2352 by 1568 pixels · CFP — 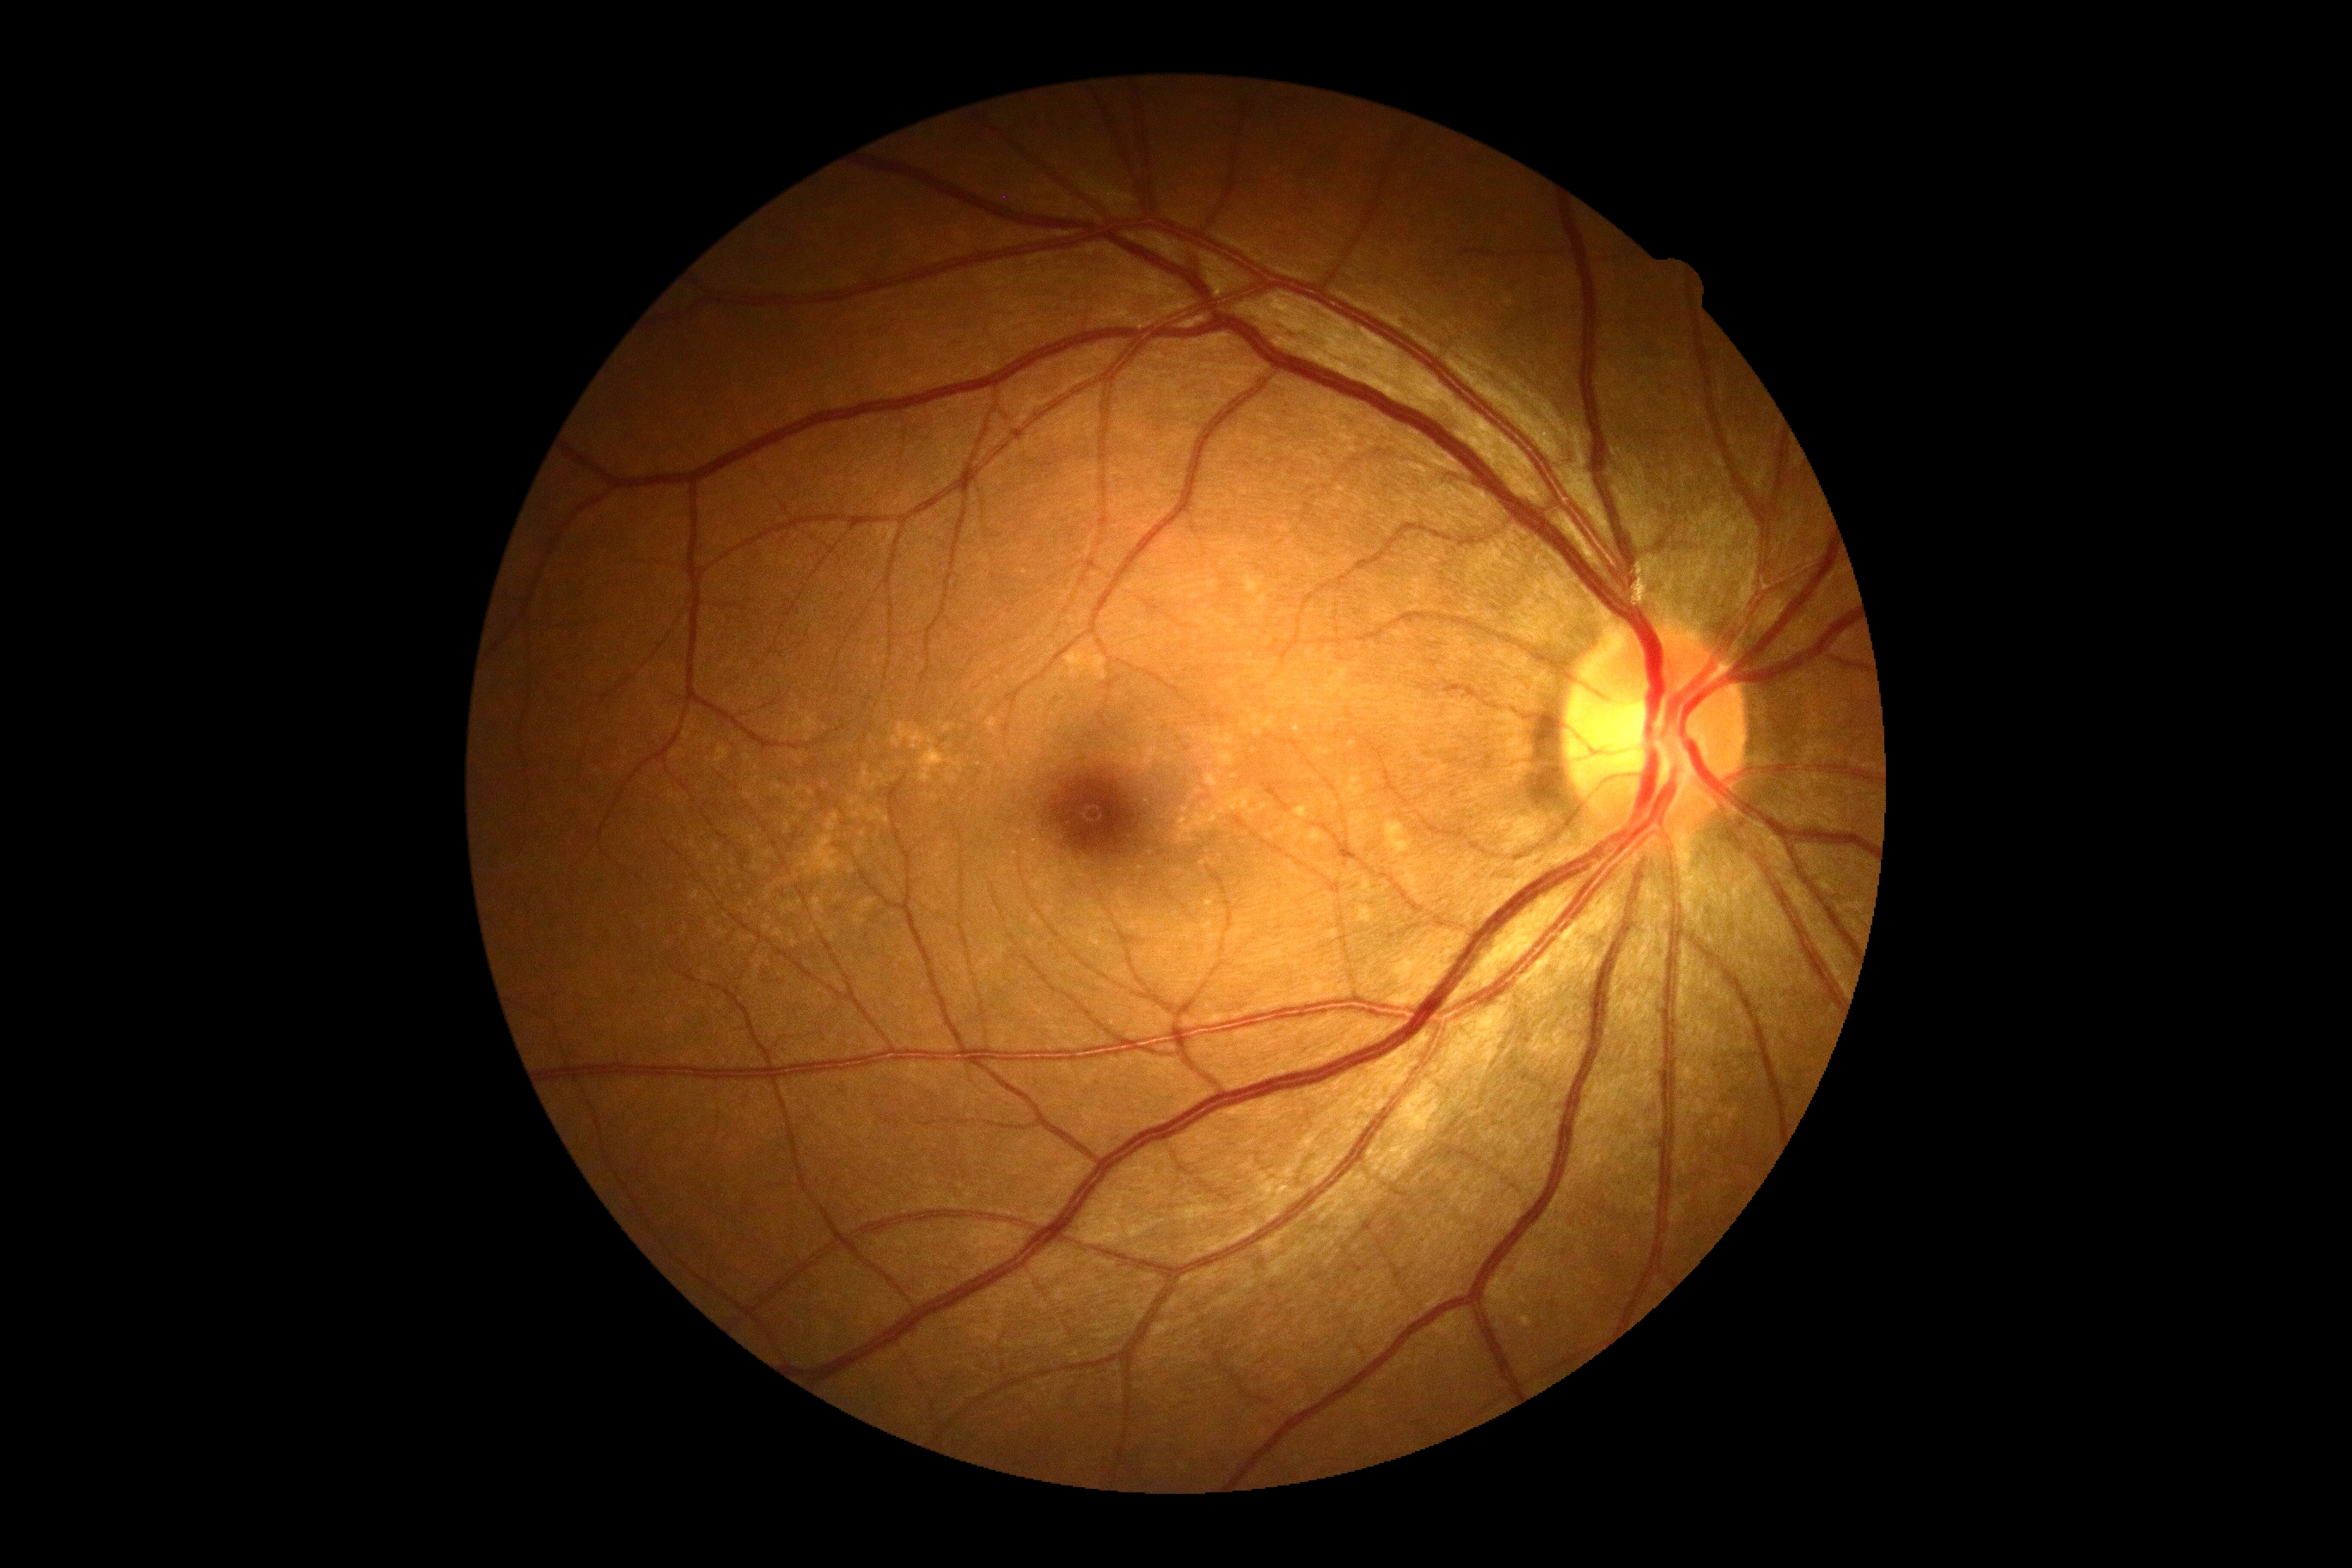 DR severity: 0/4
DR impression: negative for DR